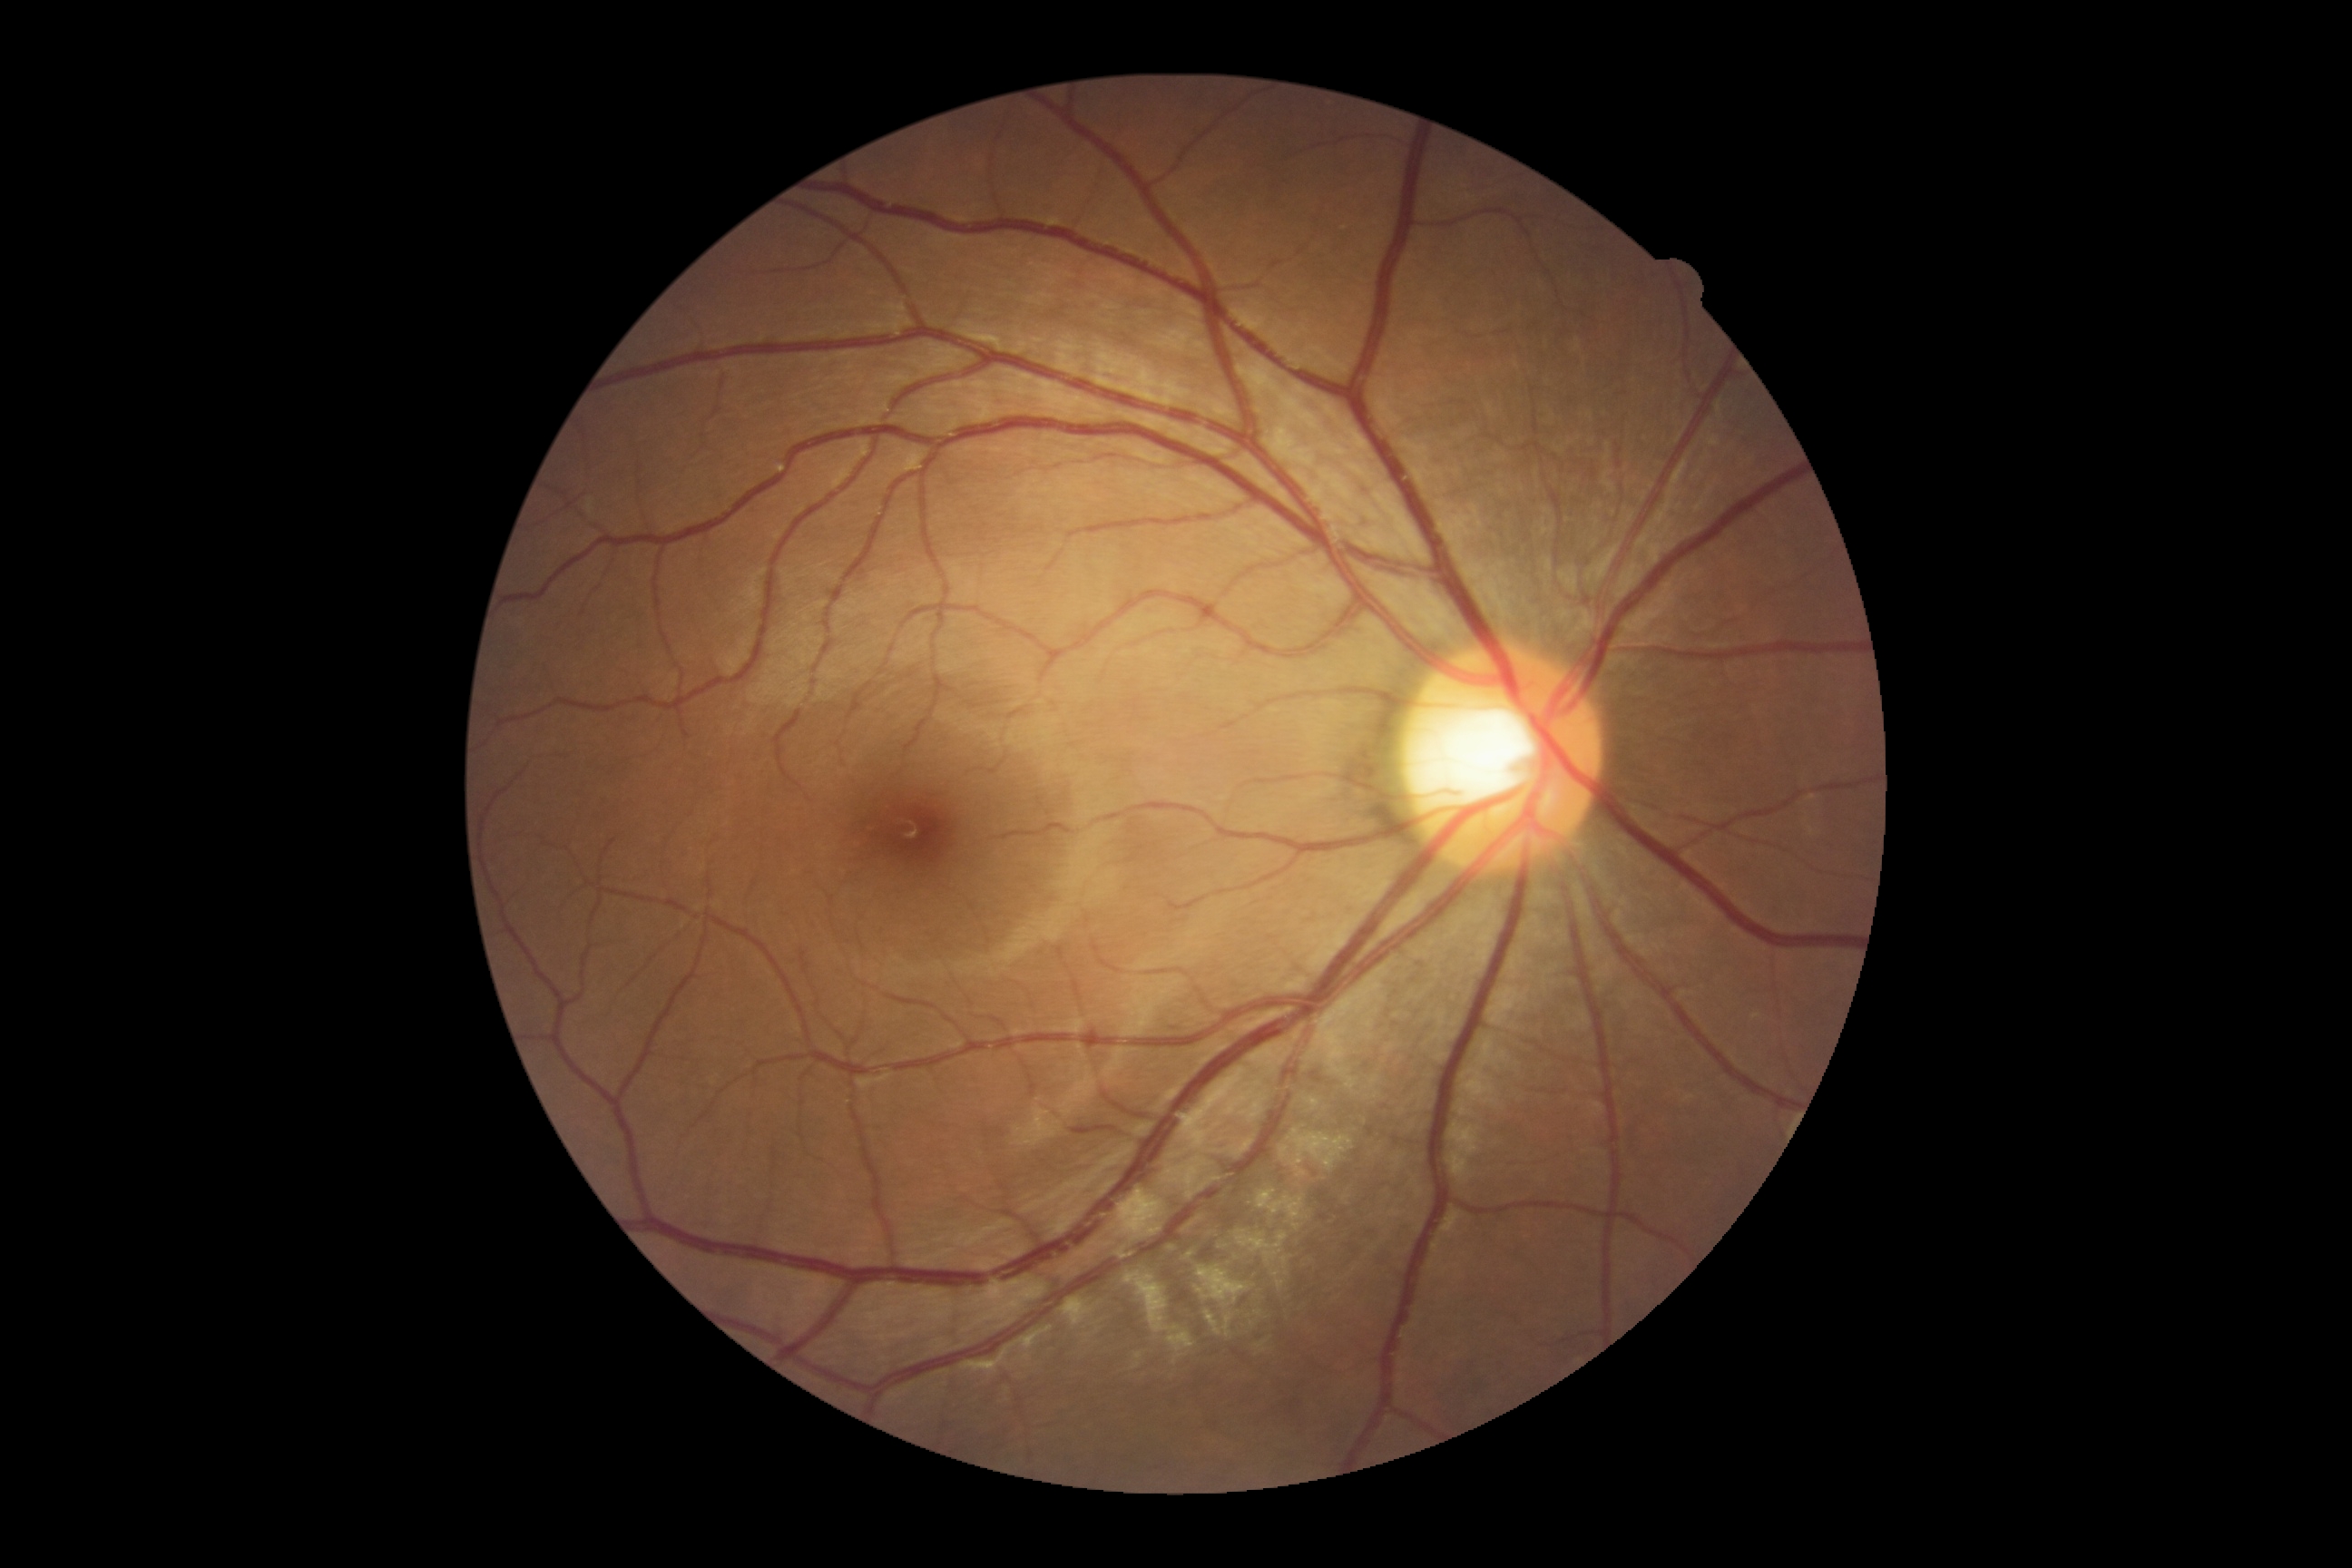
DR severity: 0/4.